2352 x 1568 pixels:
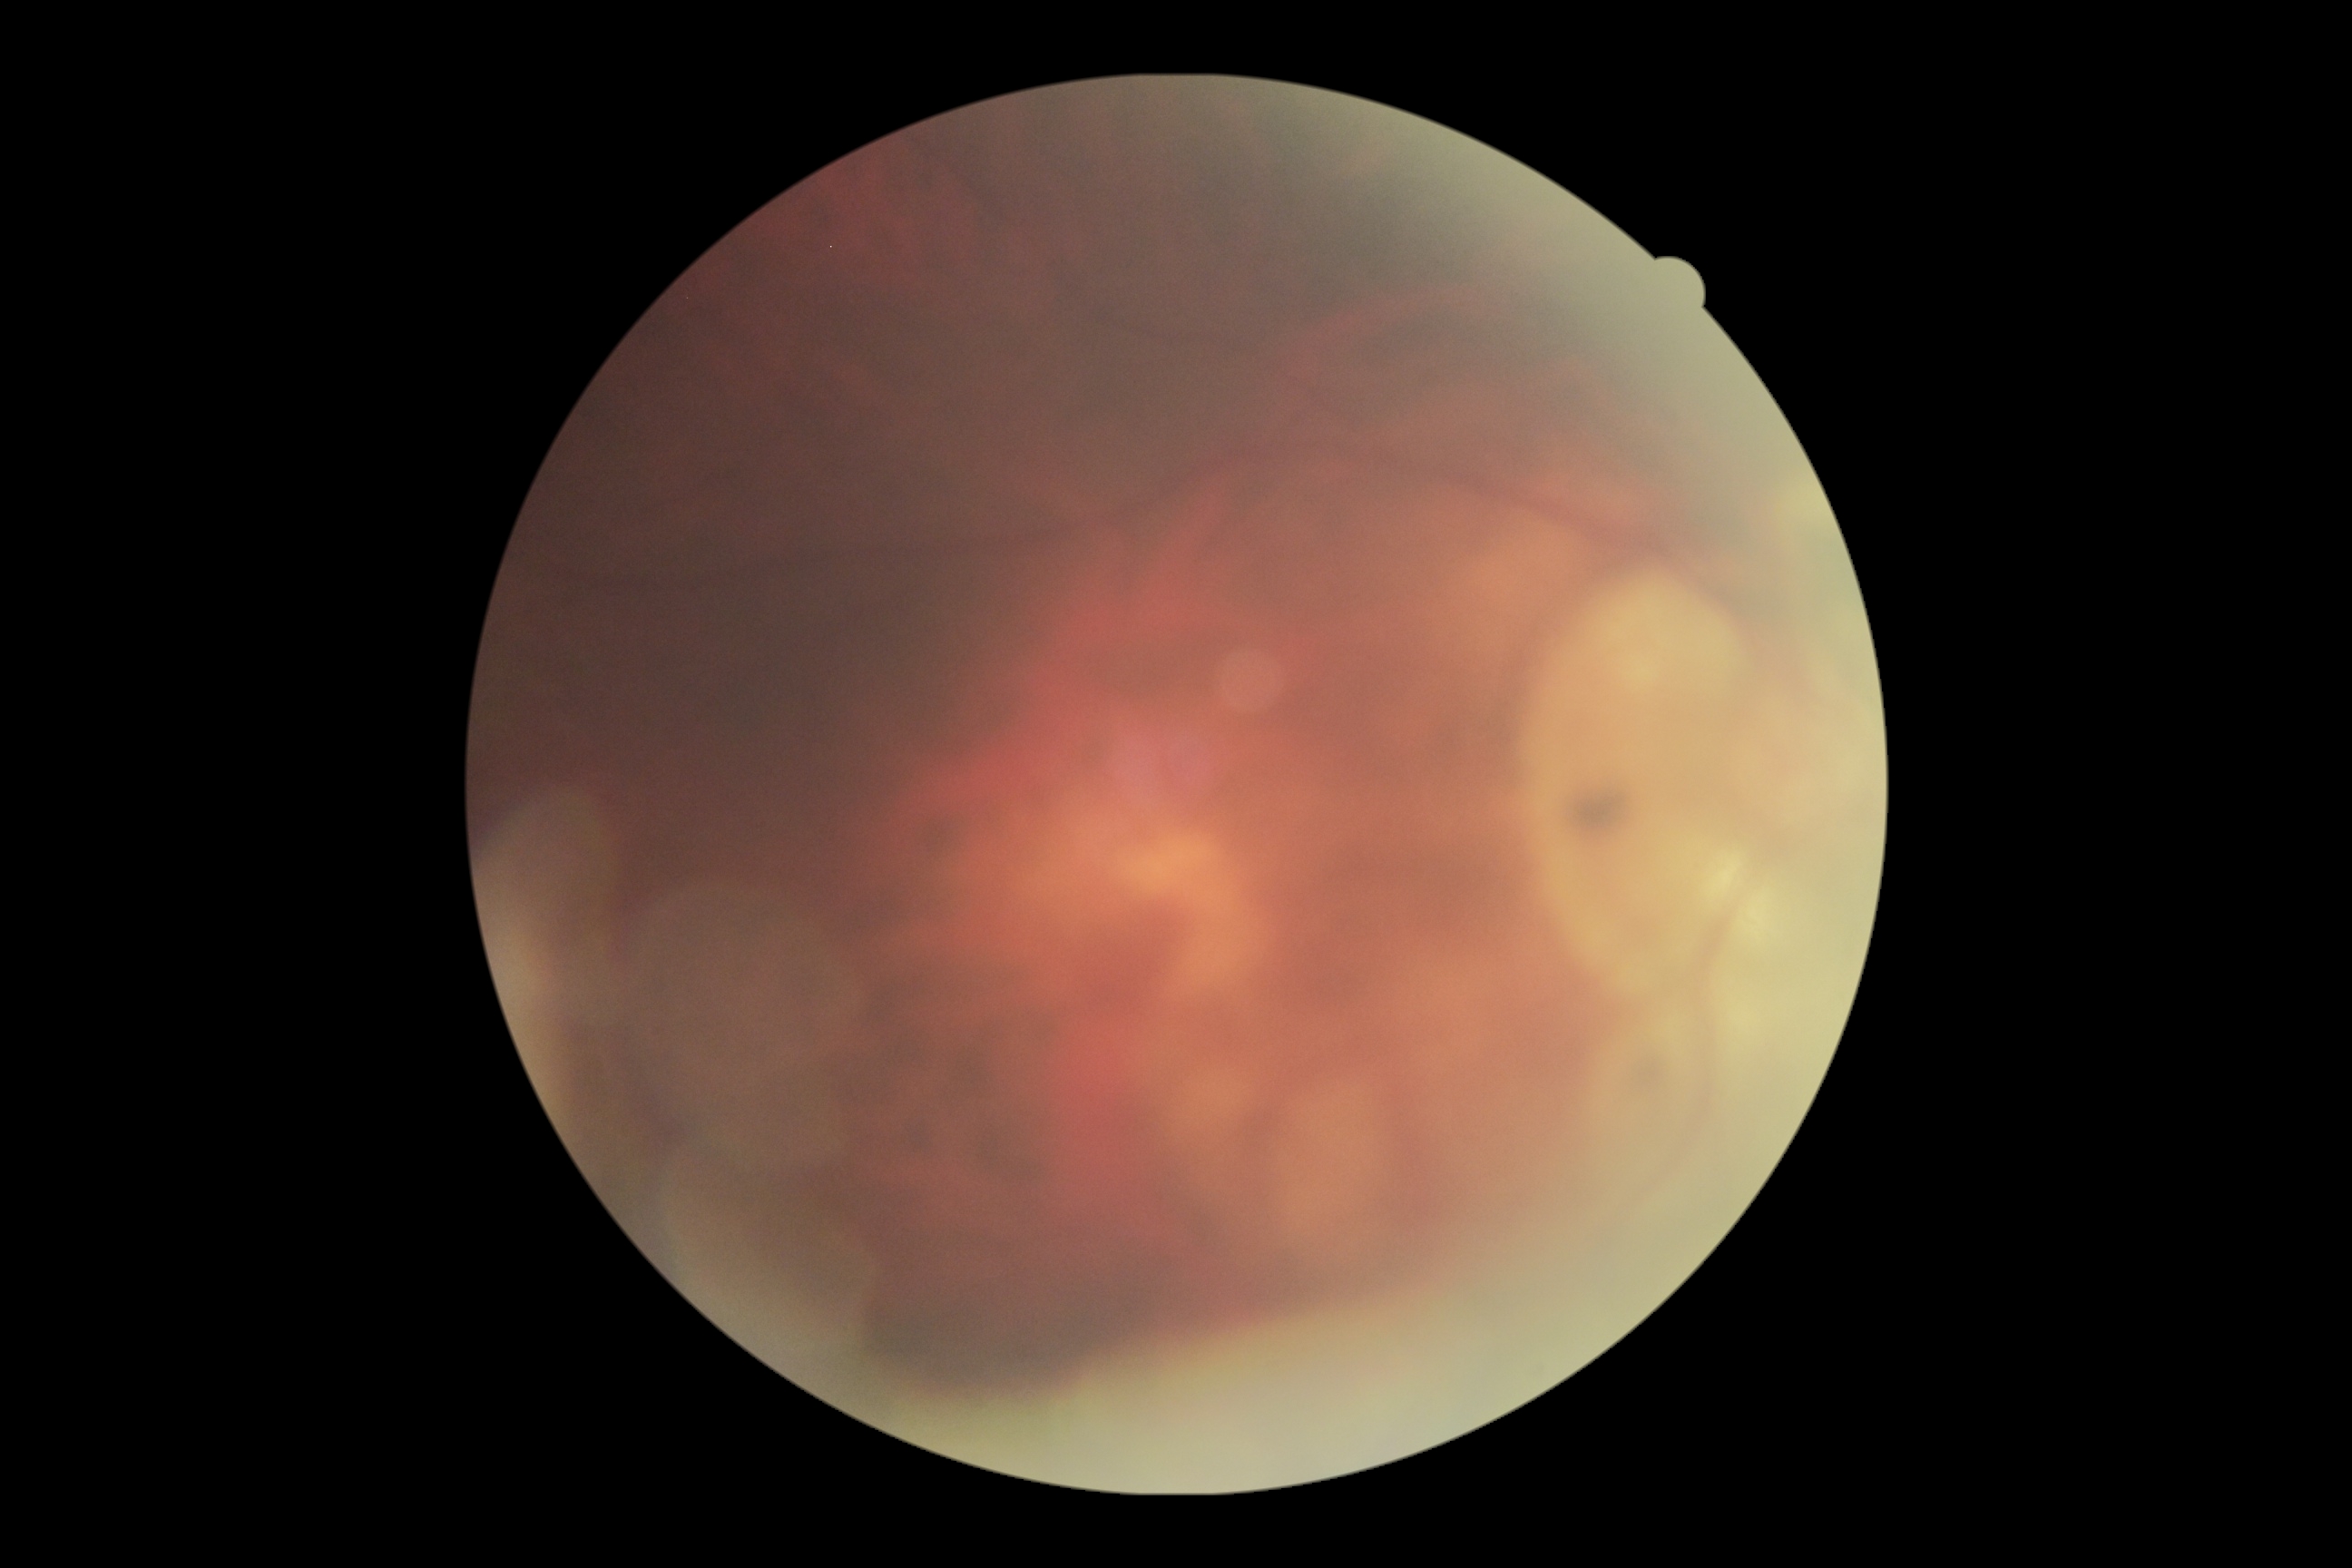
Diabetic retinopathy grade is ungradable.
The image cannot be graded for diabetic retinopathy.